848x848px: 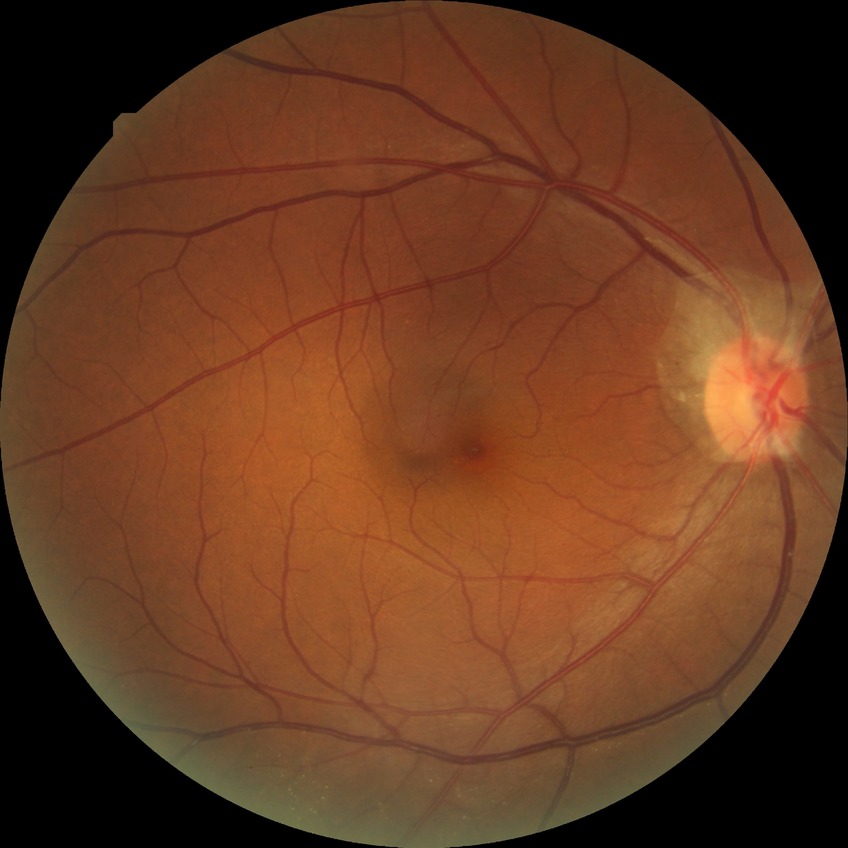
DR grade: NDR.